1240x1240 · Phoenix ICON wide-field infant fundus image.
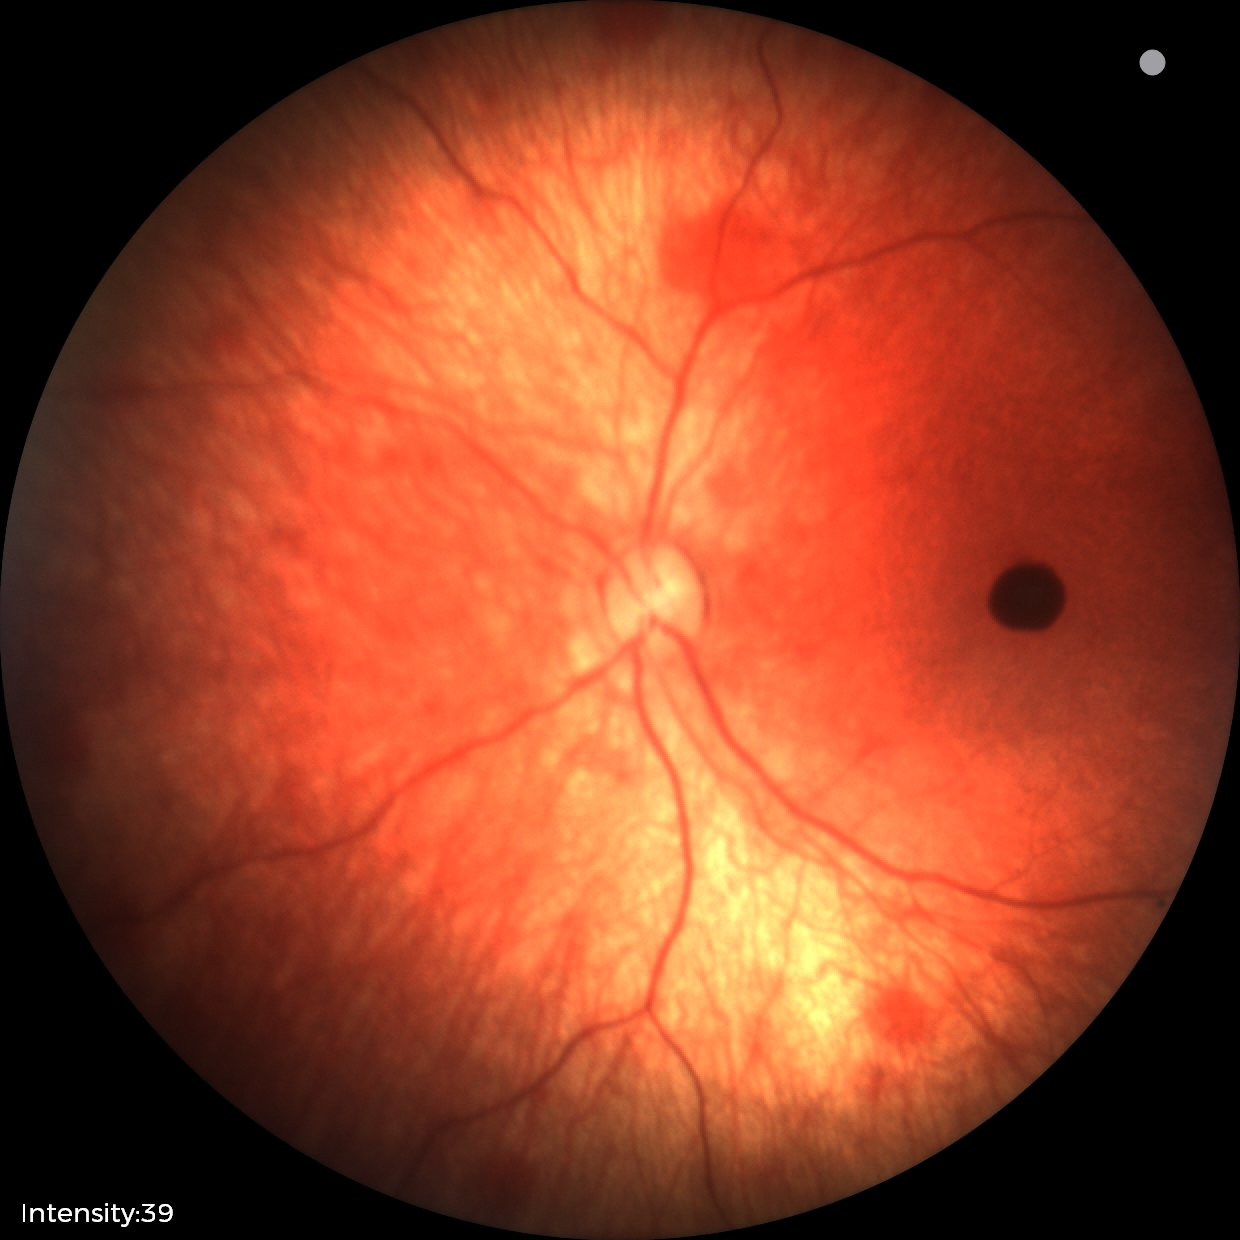
Screening series with retinal hemorrhages.